Color fundus image:
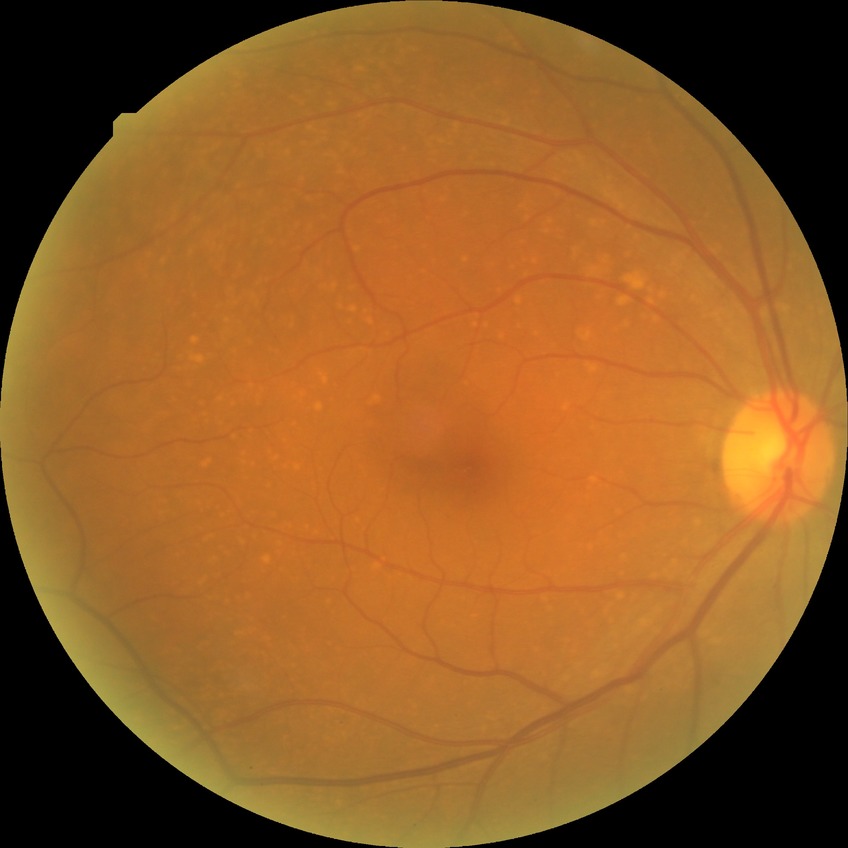
DR impression = no signs of DR | DR = NDR.